45° field of view; nonmydriatic fundus photograph.
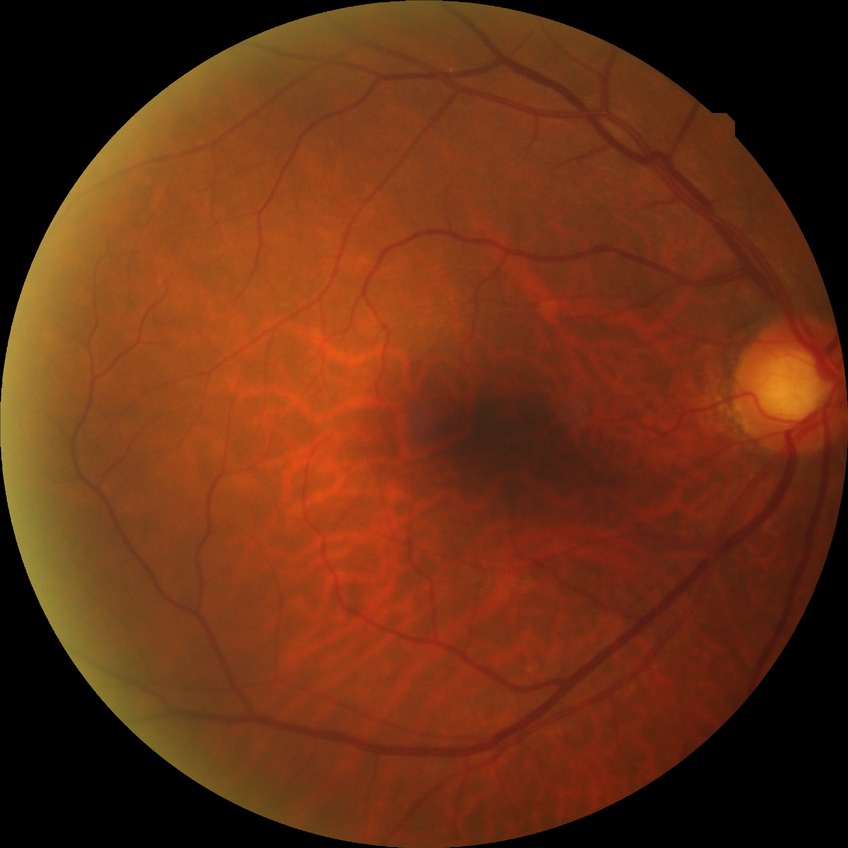

Diabetic retinopathy (DR) is NDR (no diabetic retinopathy).